CFP:
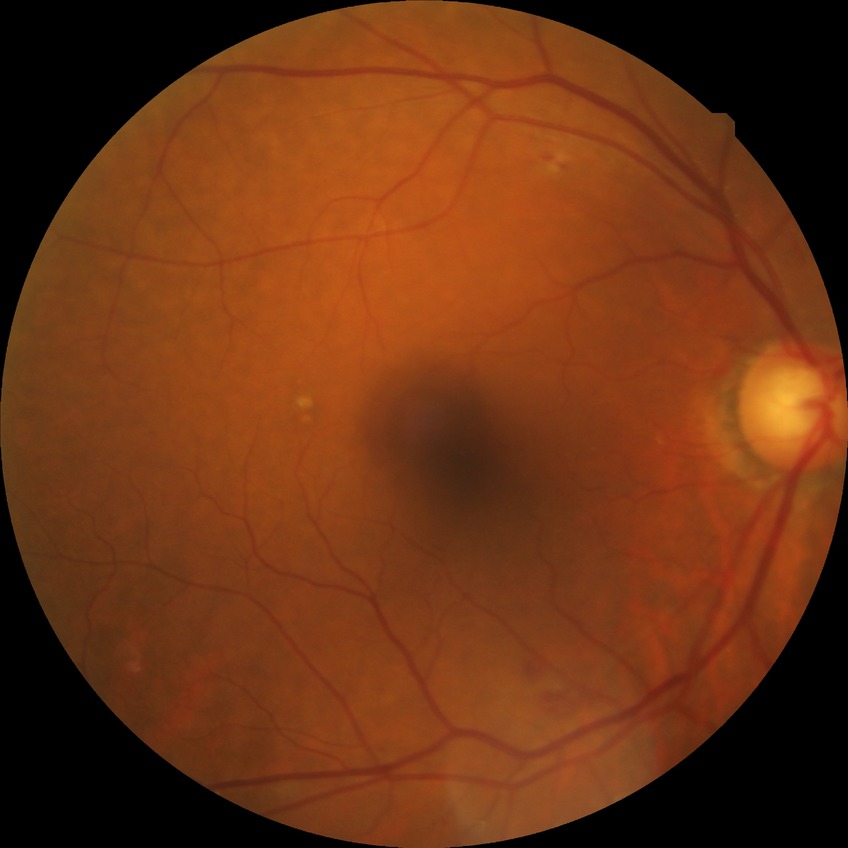 diabetic retinopathy (DR)@SDR (simple diabetic retinopathy).